Camera: Clarity RetCam 3 (130° FOV); 640x480px; wide-field fundus image from infant ROP screening: 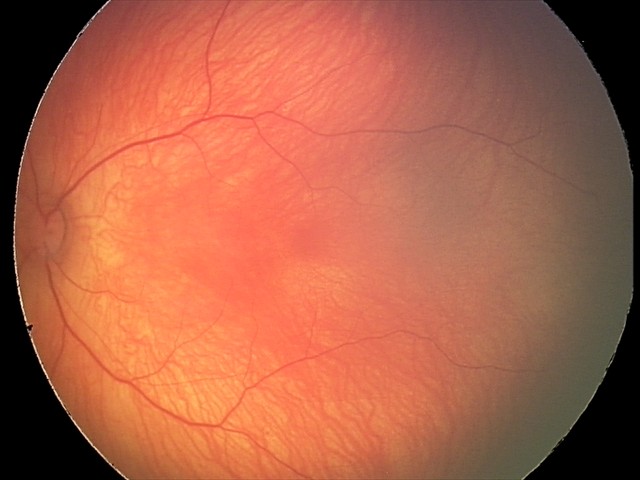 Screening: normal retinal appearance.